RetCam wide-field infant fundus image
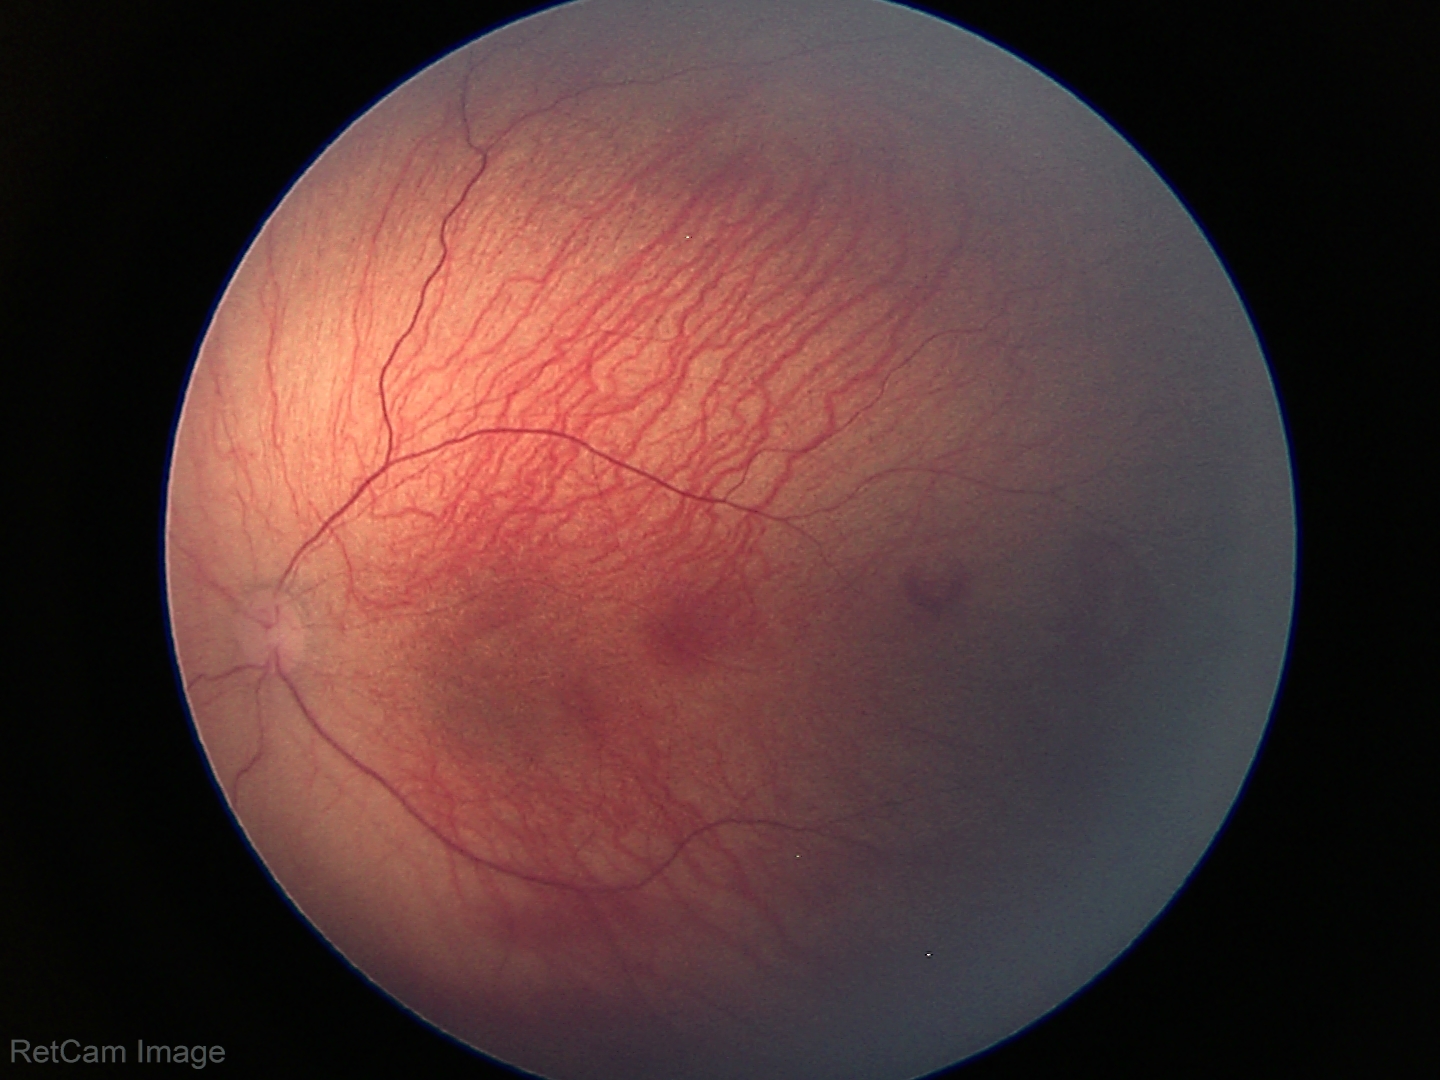 Screening series with ROP stage 1.